45° field of view · diabetic retinopathy graded by the modified Davis classification · without pupil dilation · 848 by 848 pixels · camera: NIDEK AFC-230 · CFP
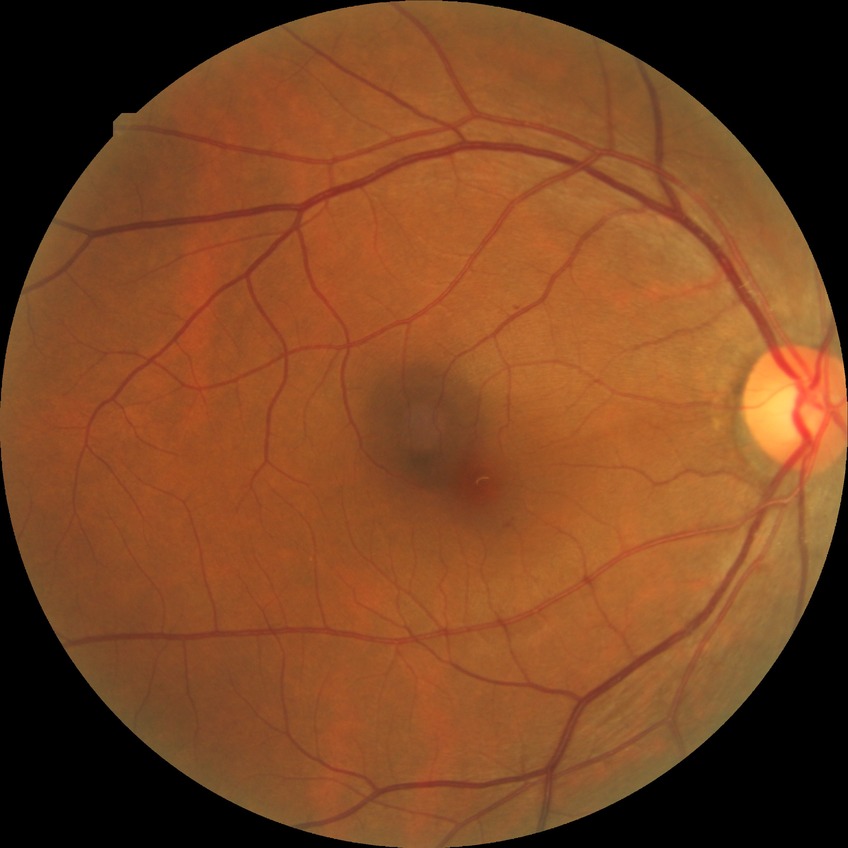 Retinopathy stage is simple diabetic retinopathy.